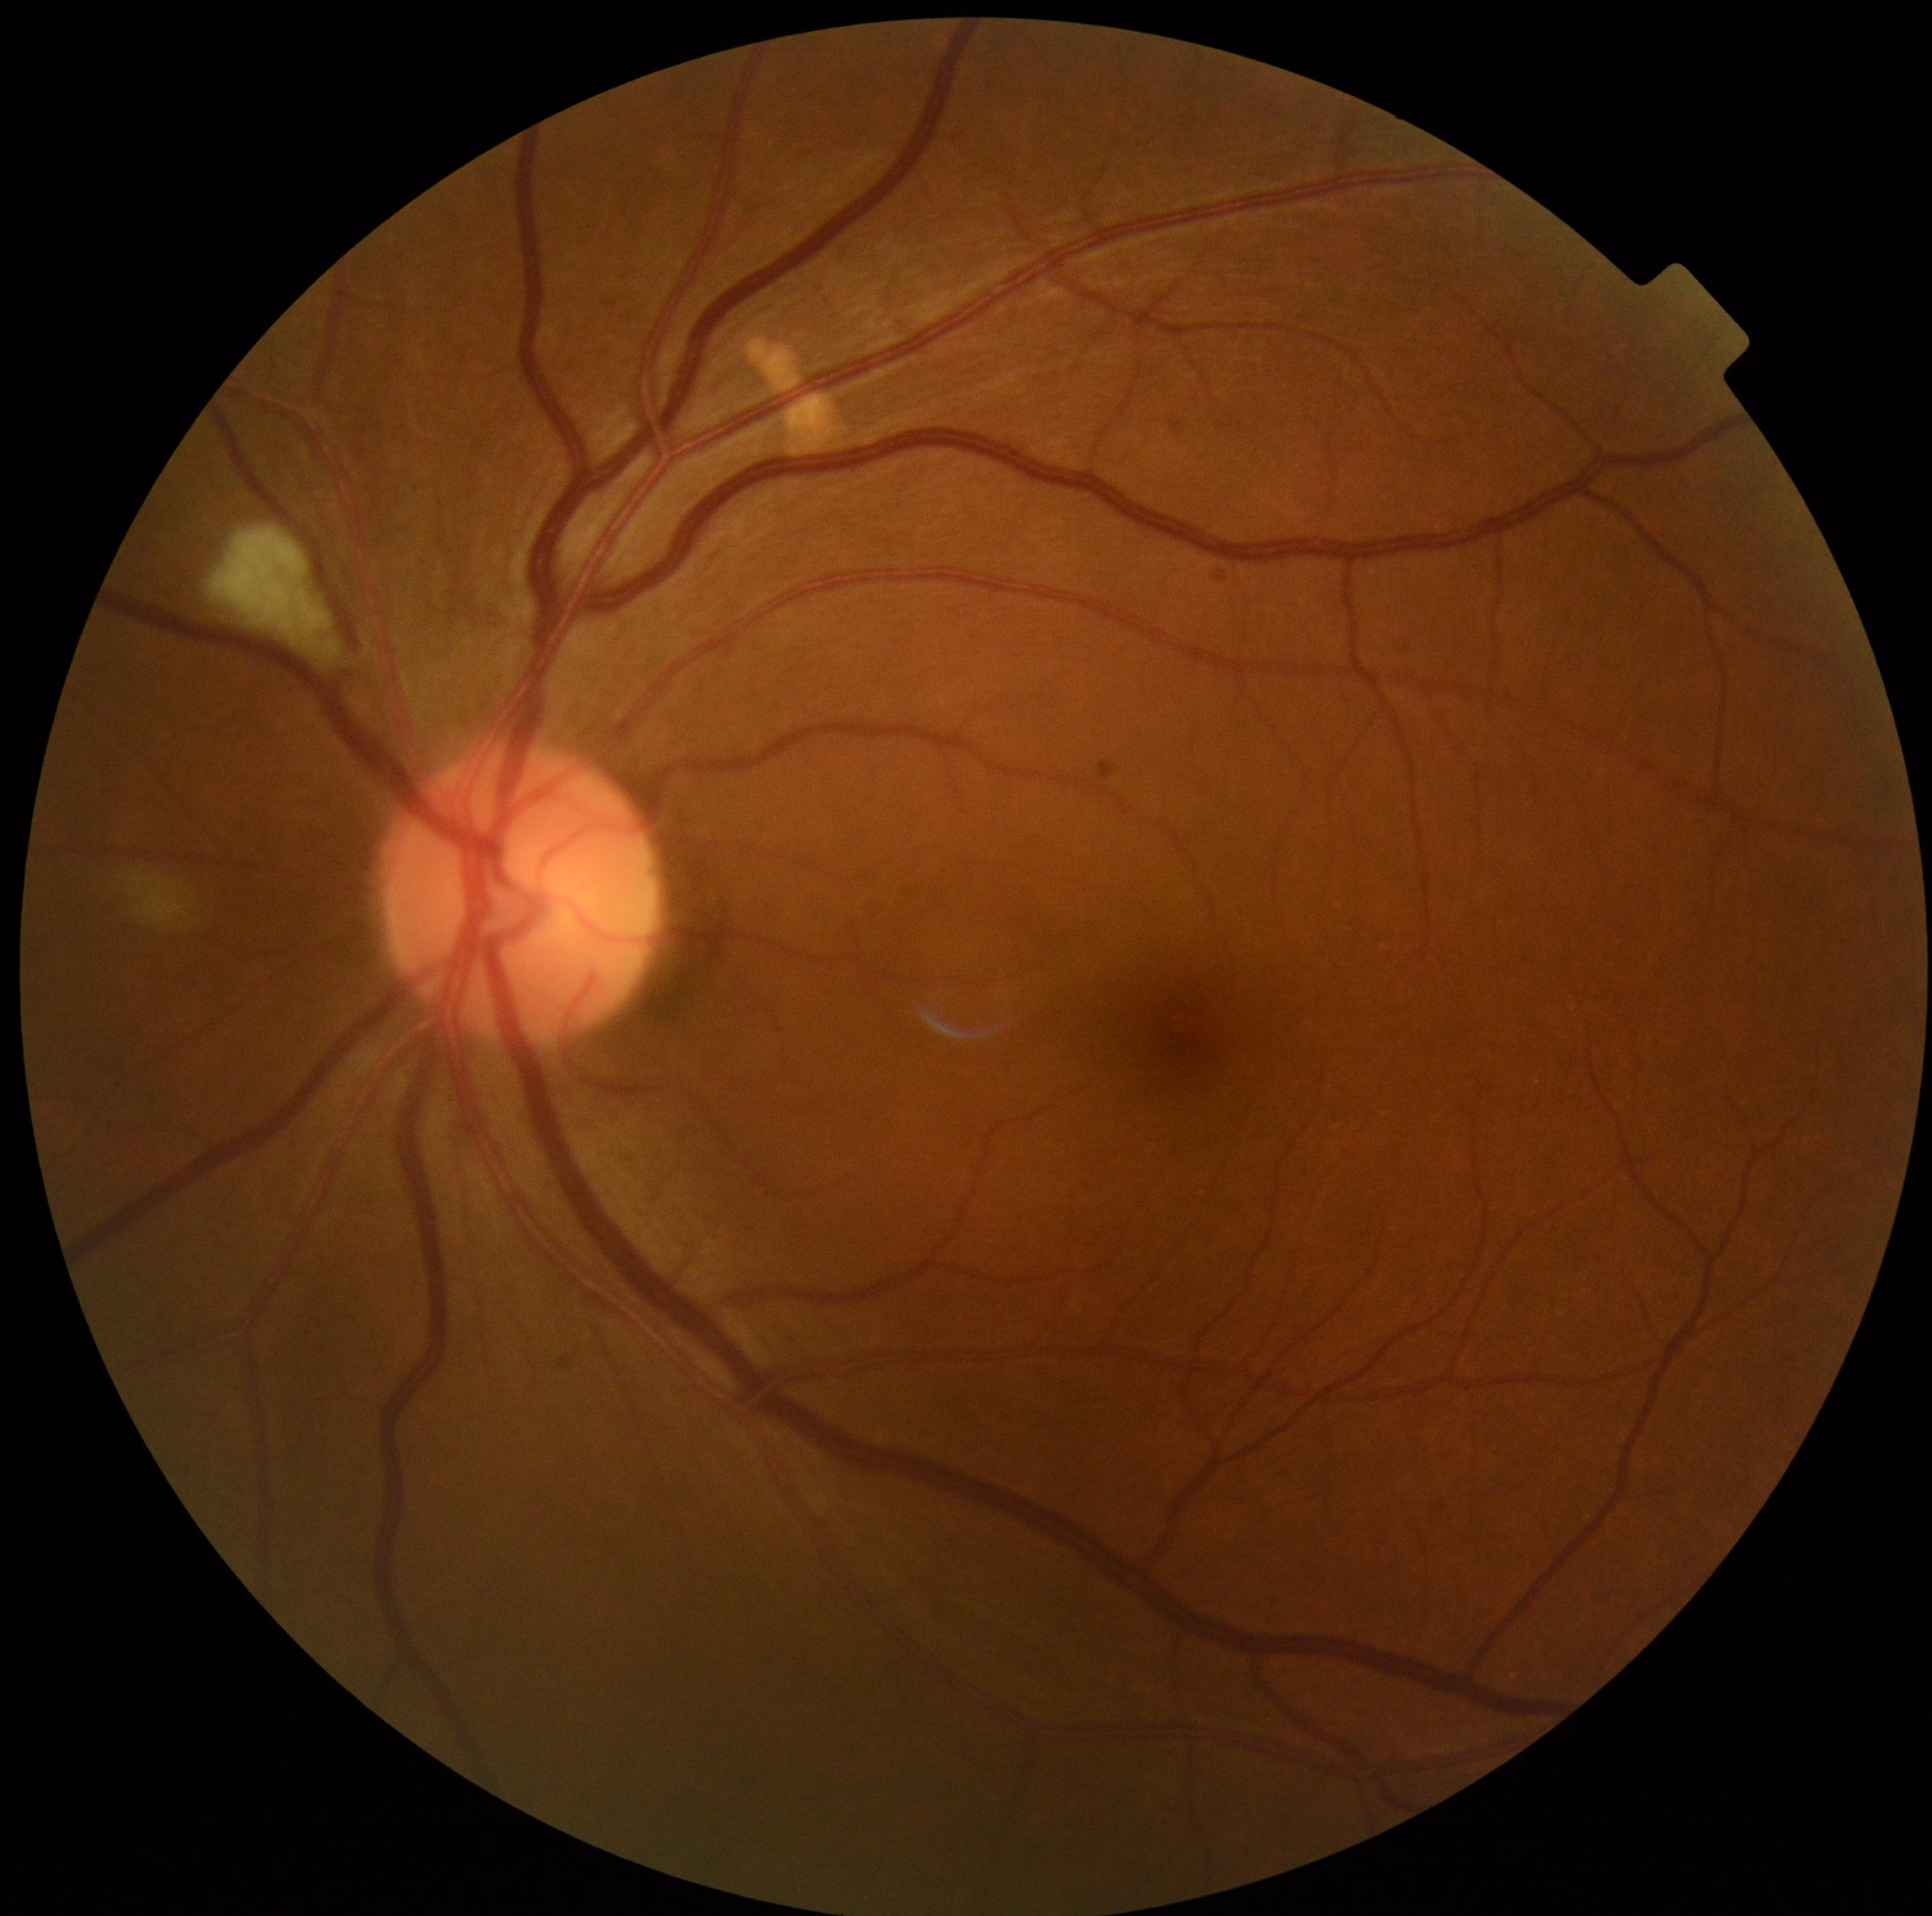
dr_grade: 2